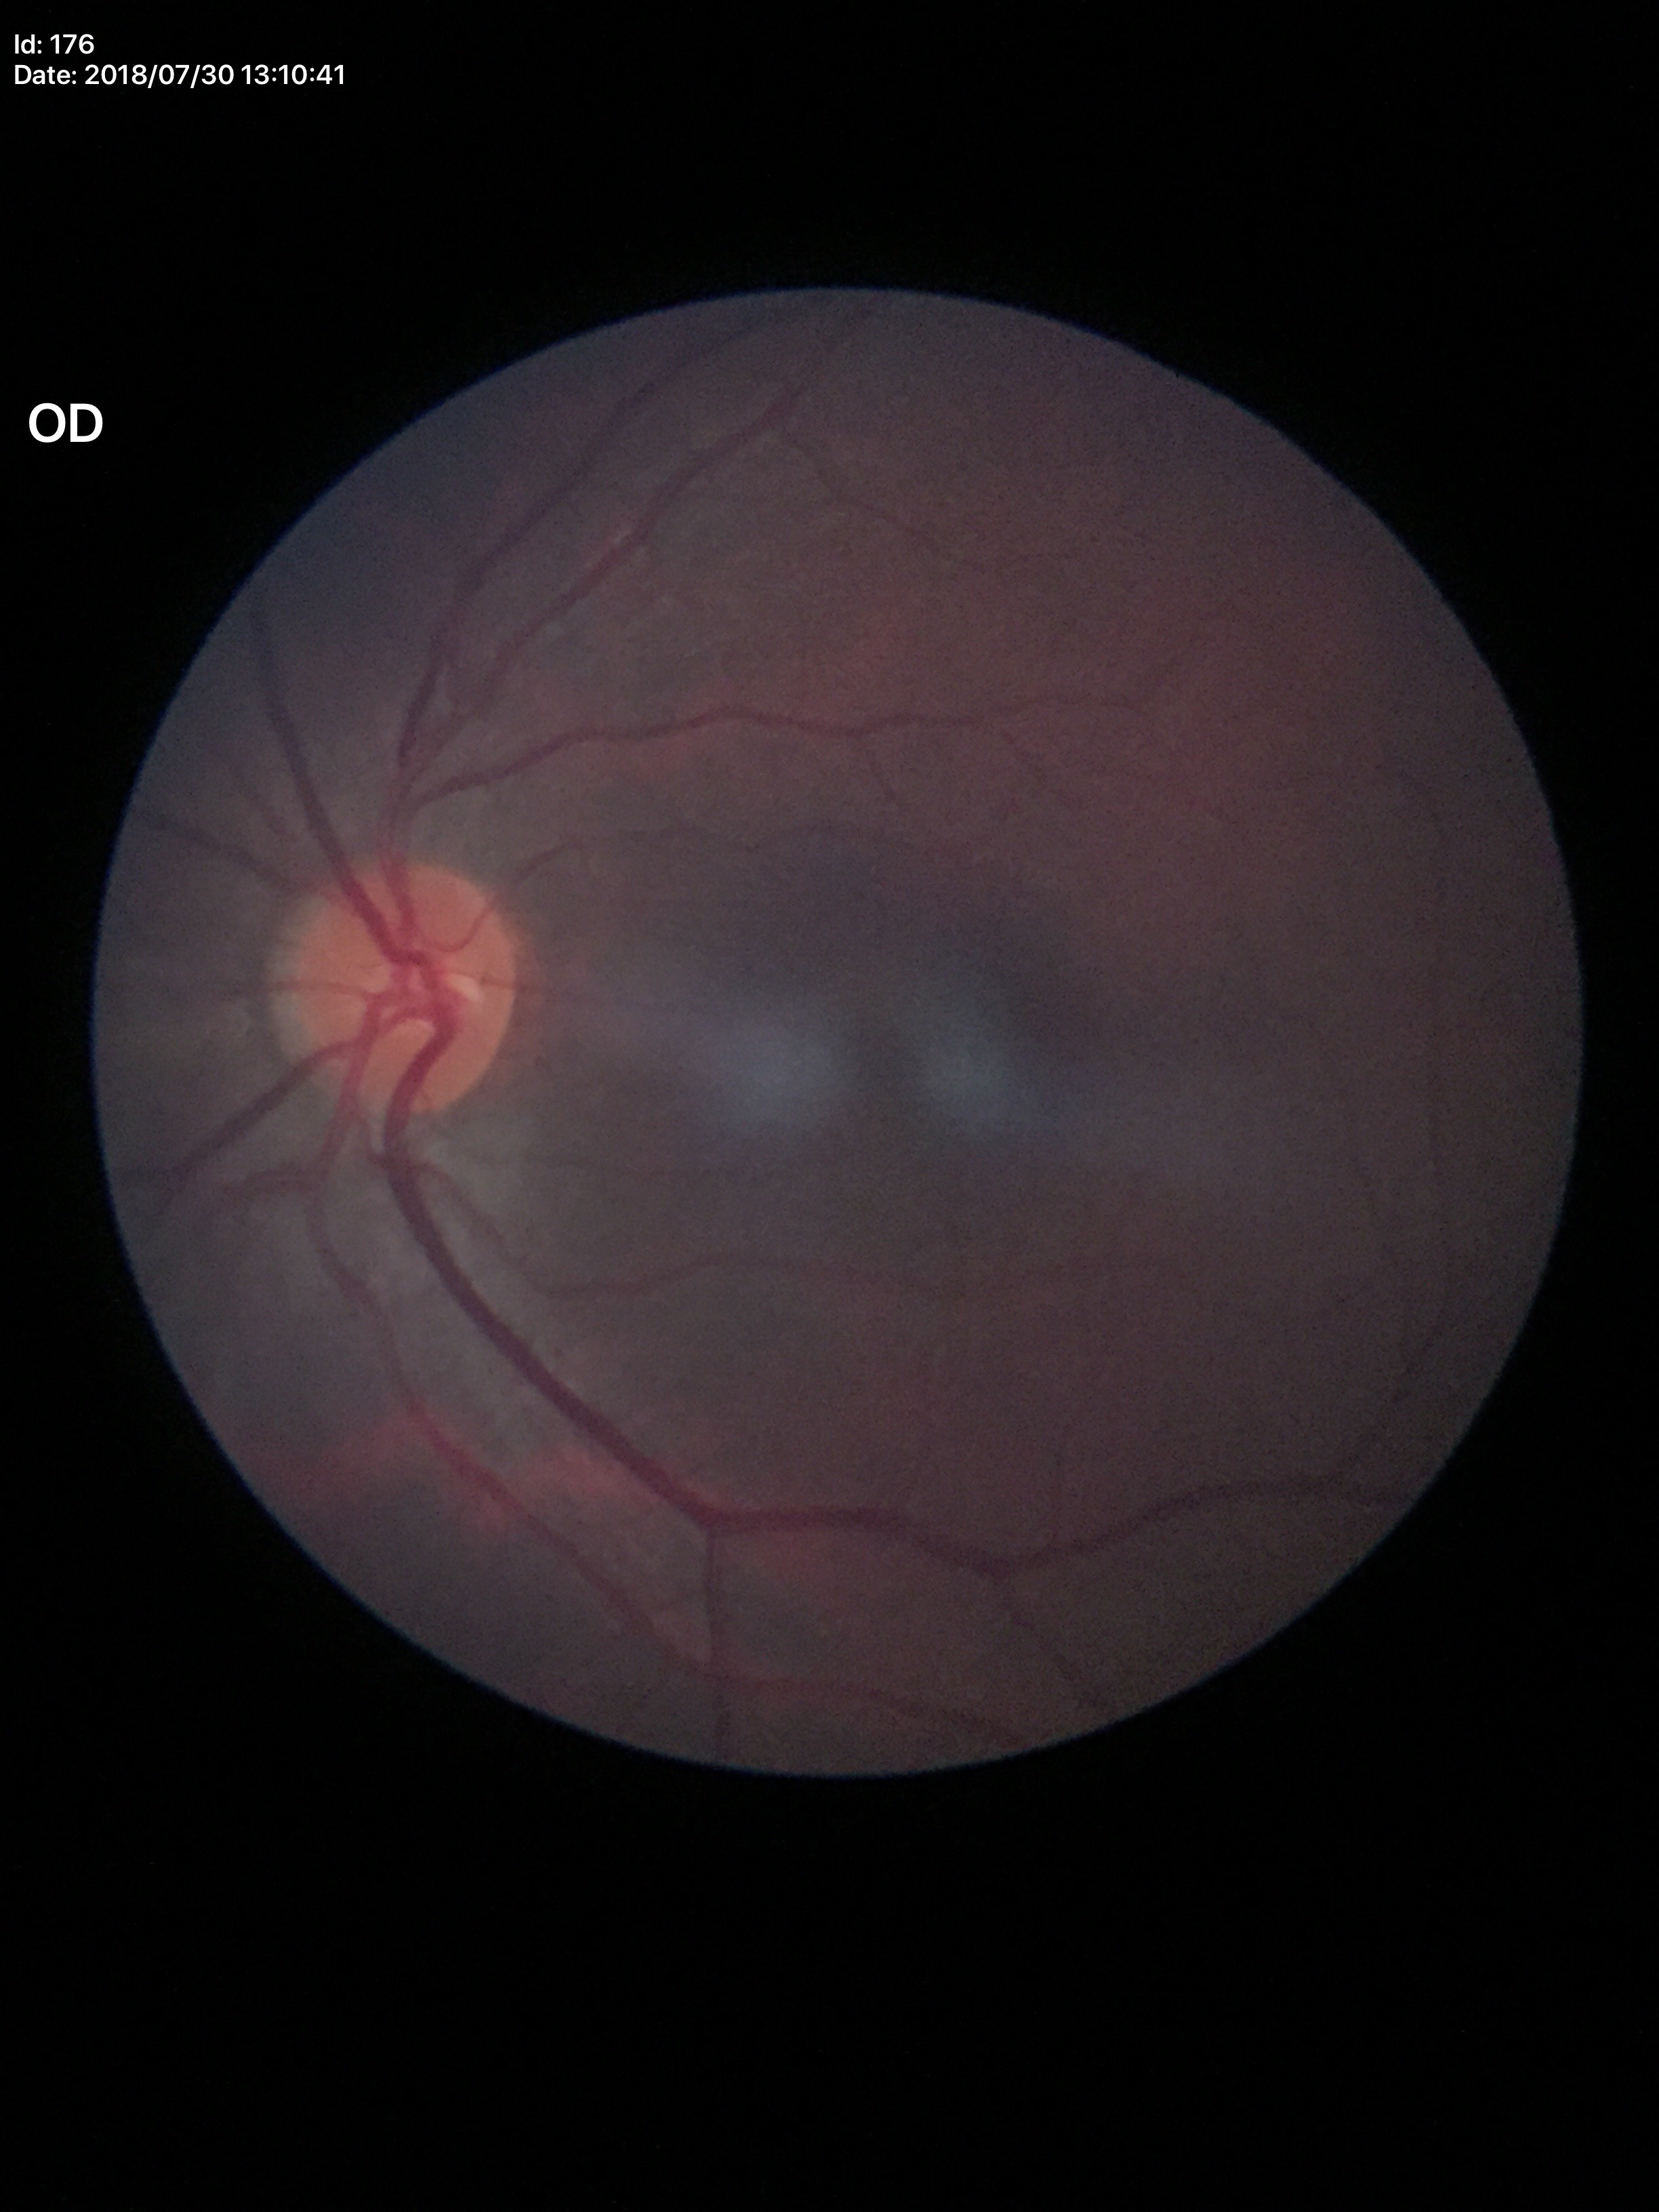 area cup-disc ratio=0.21; Glaucoma impression=not suspect; vertical cup-to-disc ratio=0.42